45-degree field of view · 1380x1382px · retinal fundus photograph: 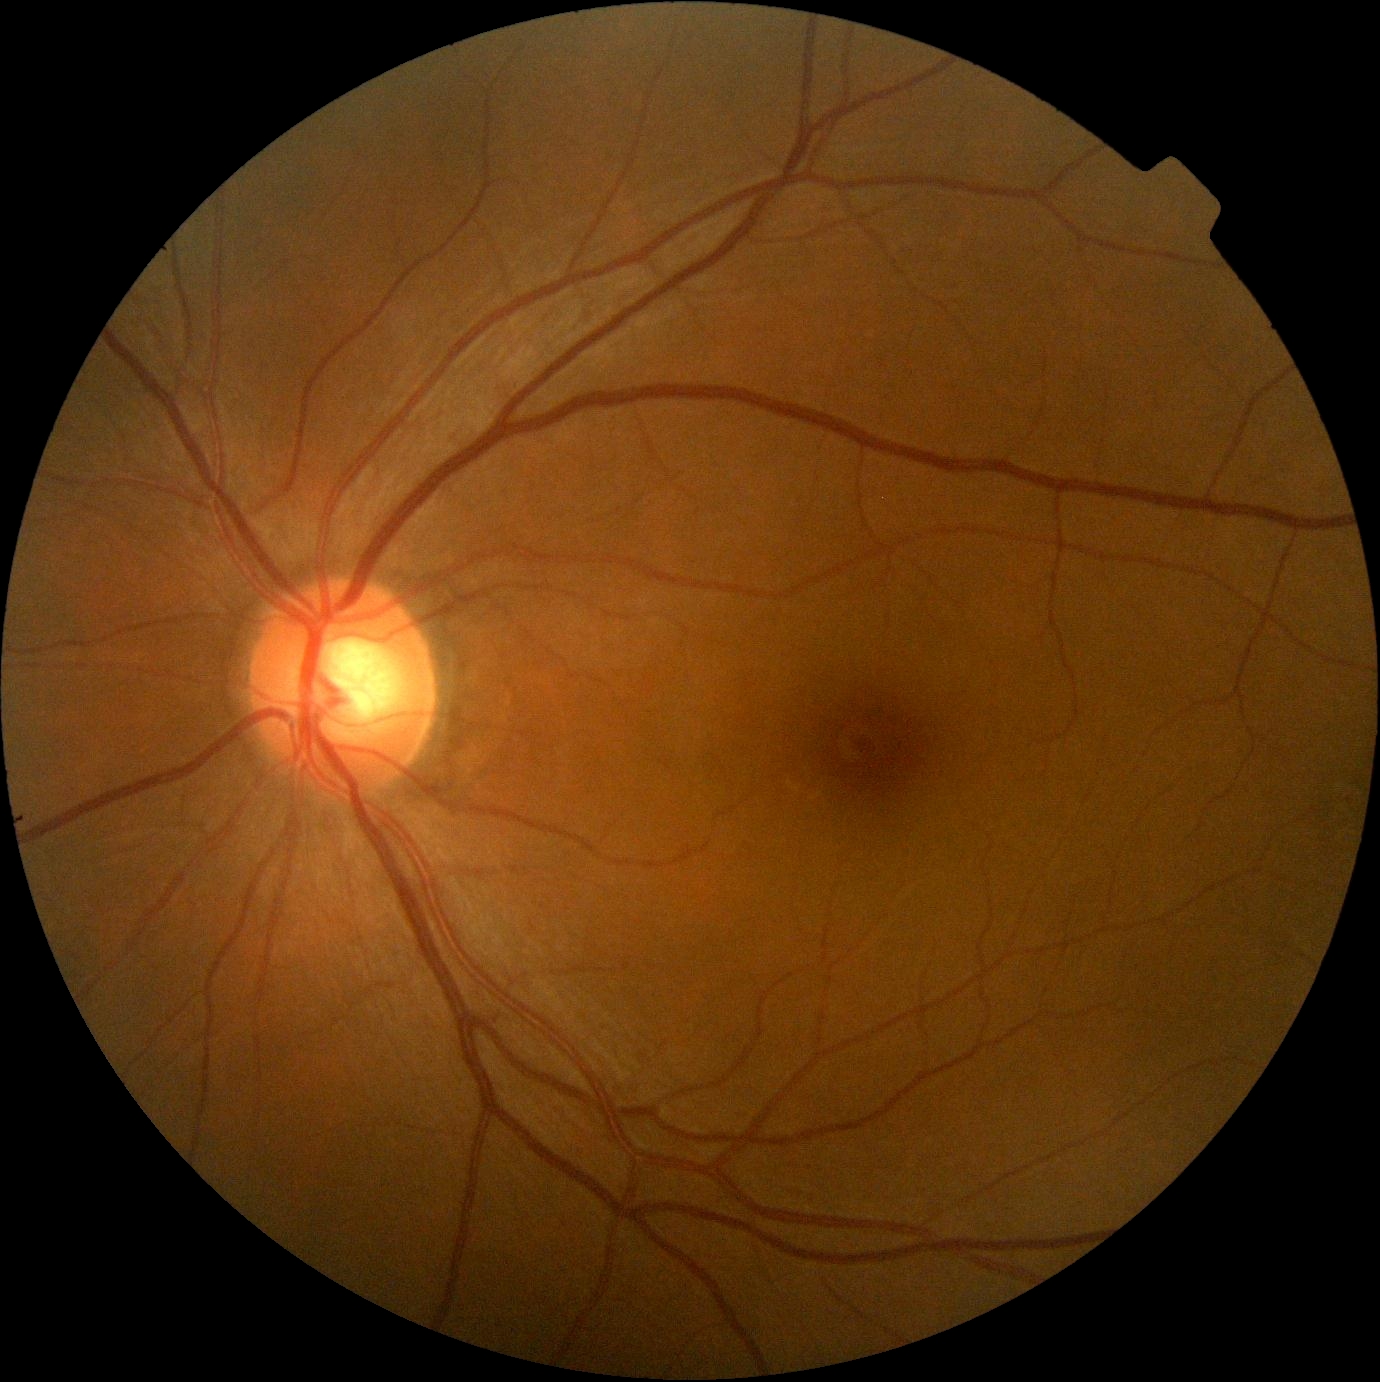

DR severity is 0/4.